Color fundus image · 45-degree field of view
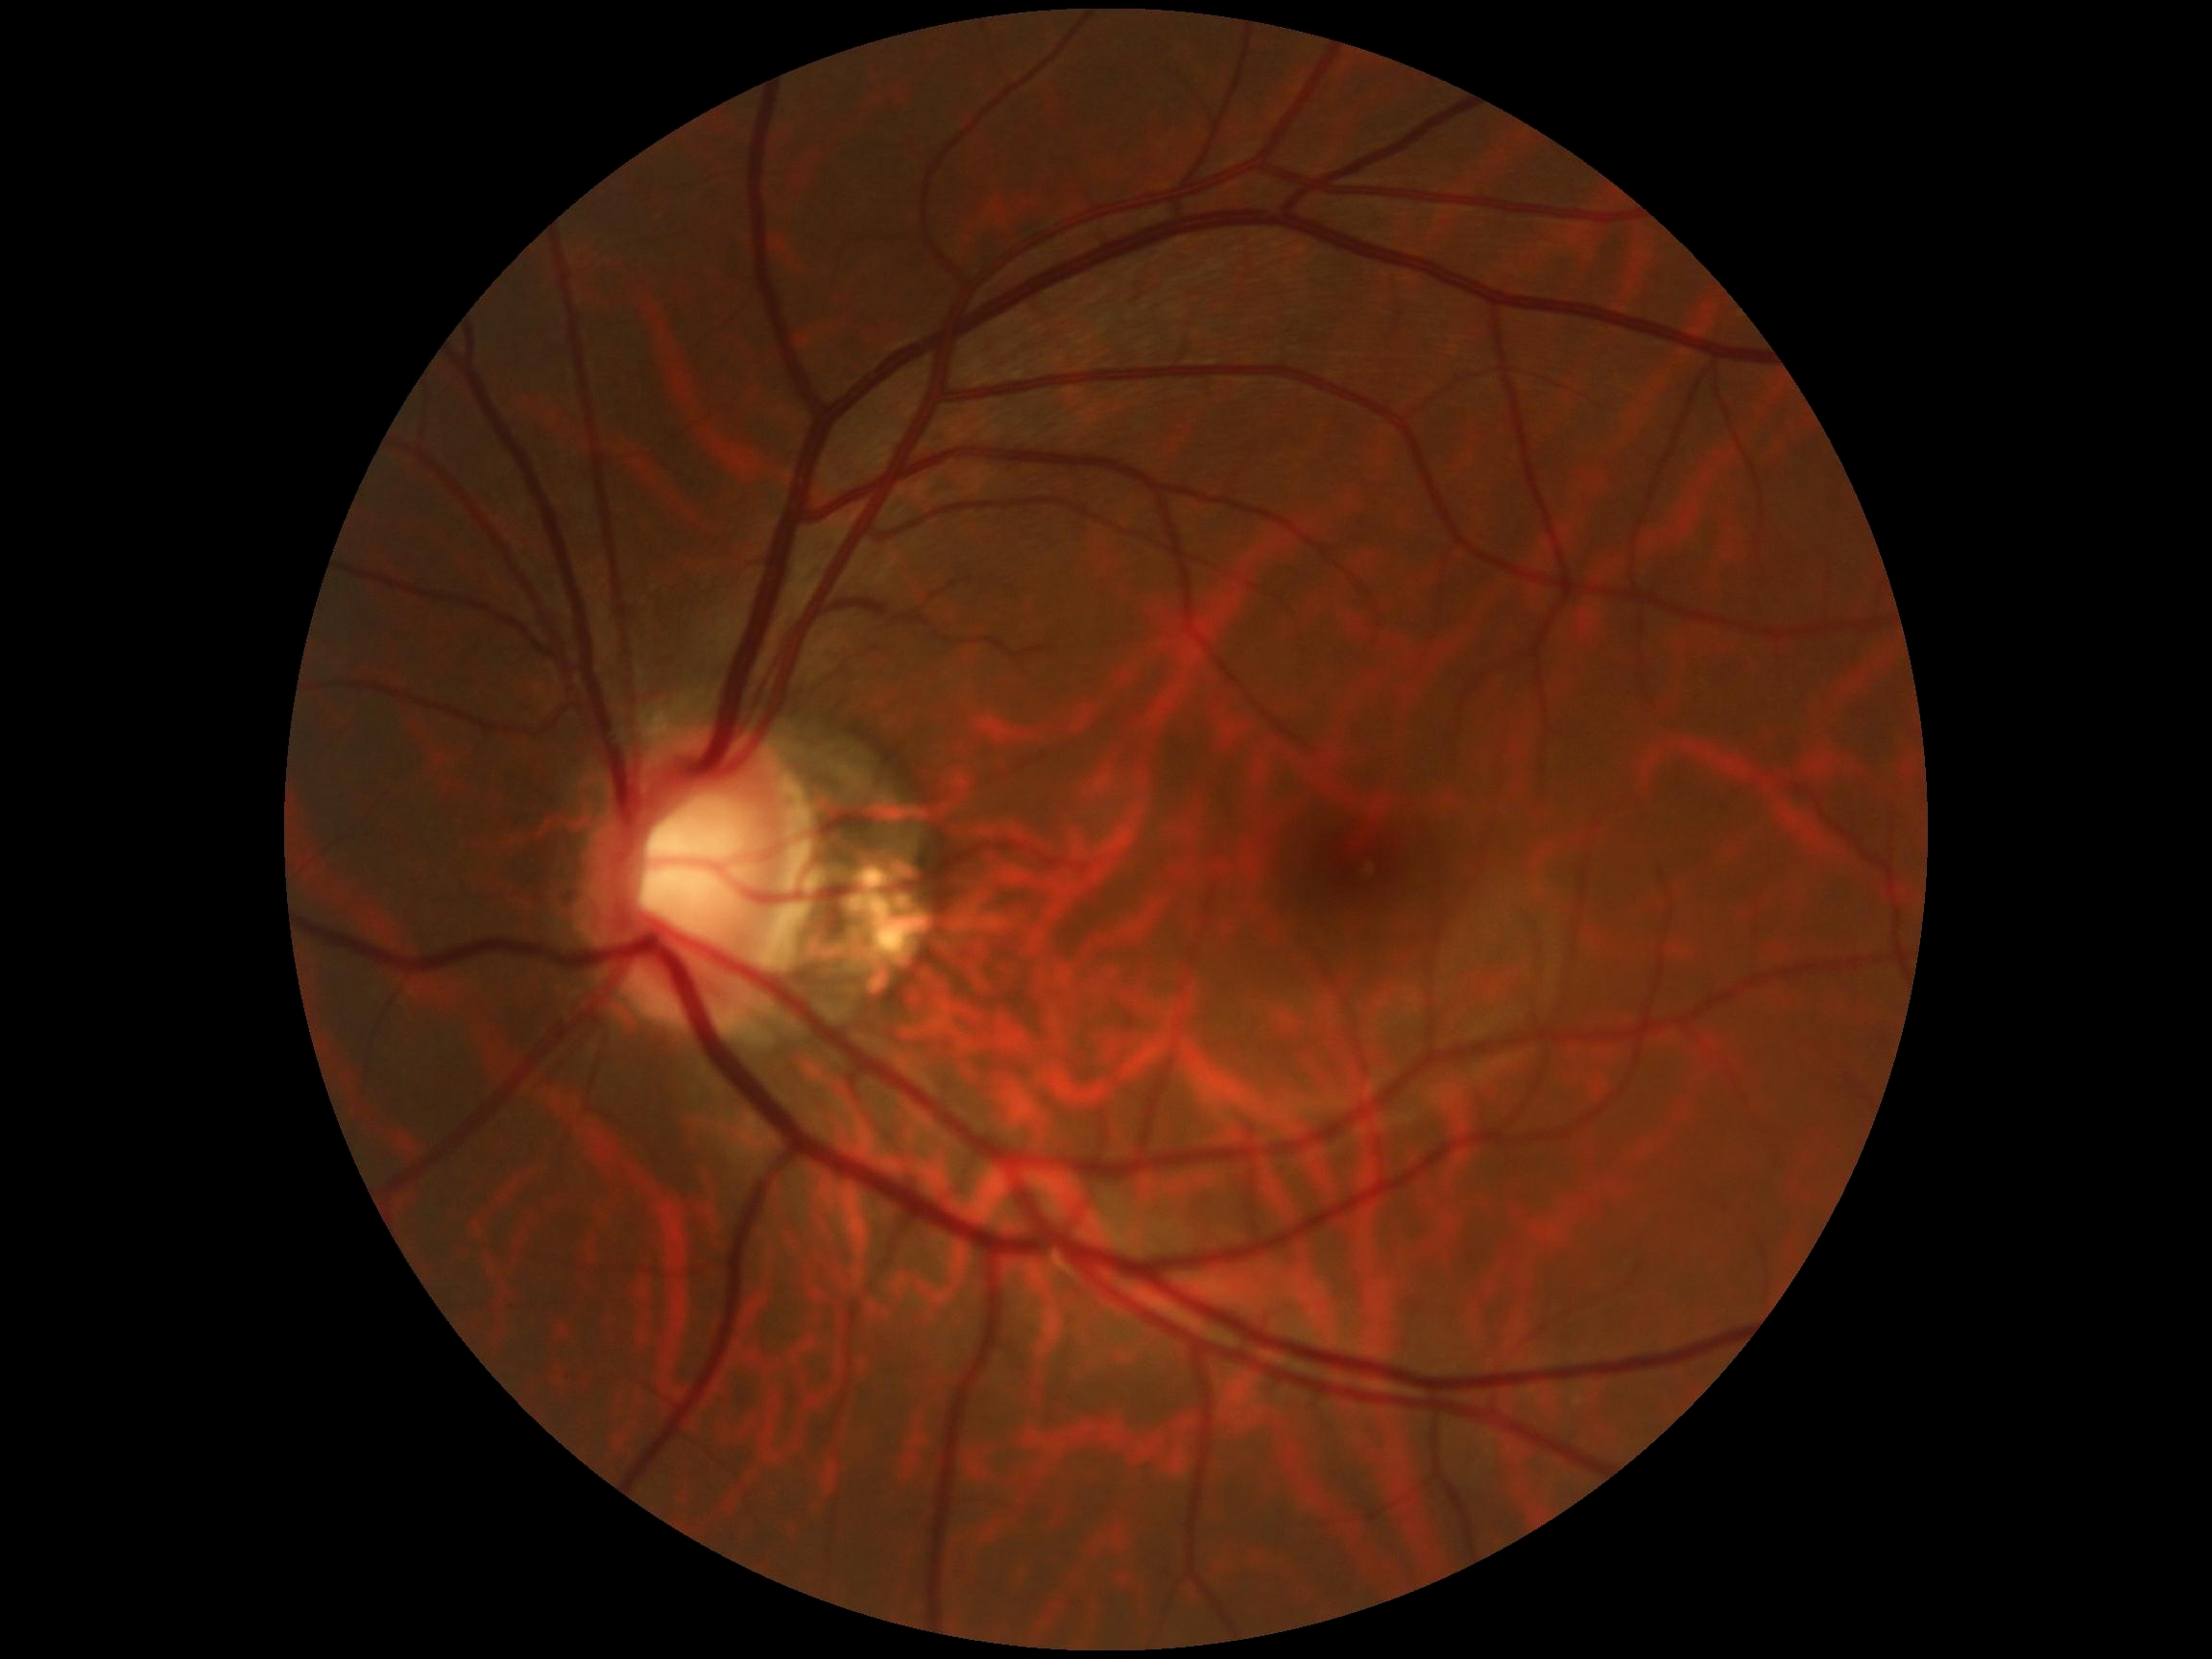
{
  "dr_impression": "no DR findings",
  "dr_grade": "grade 0"
}